Infant wide-field fundus photograph — 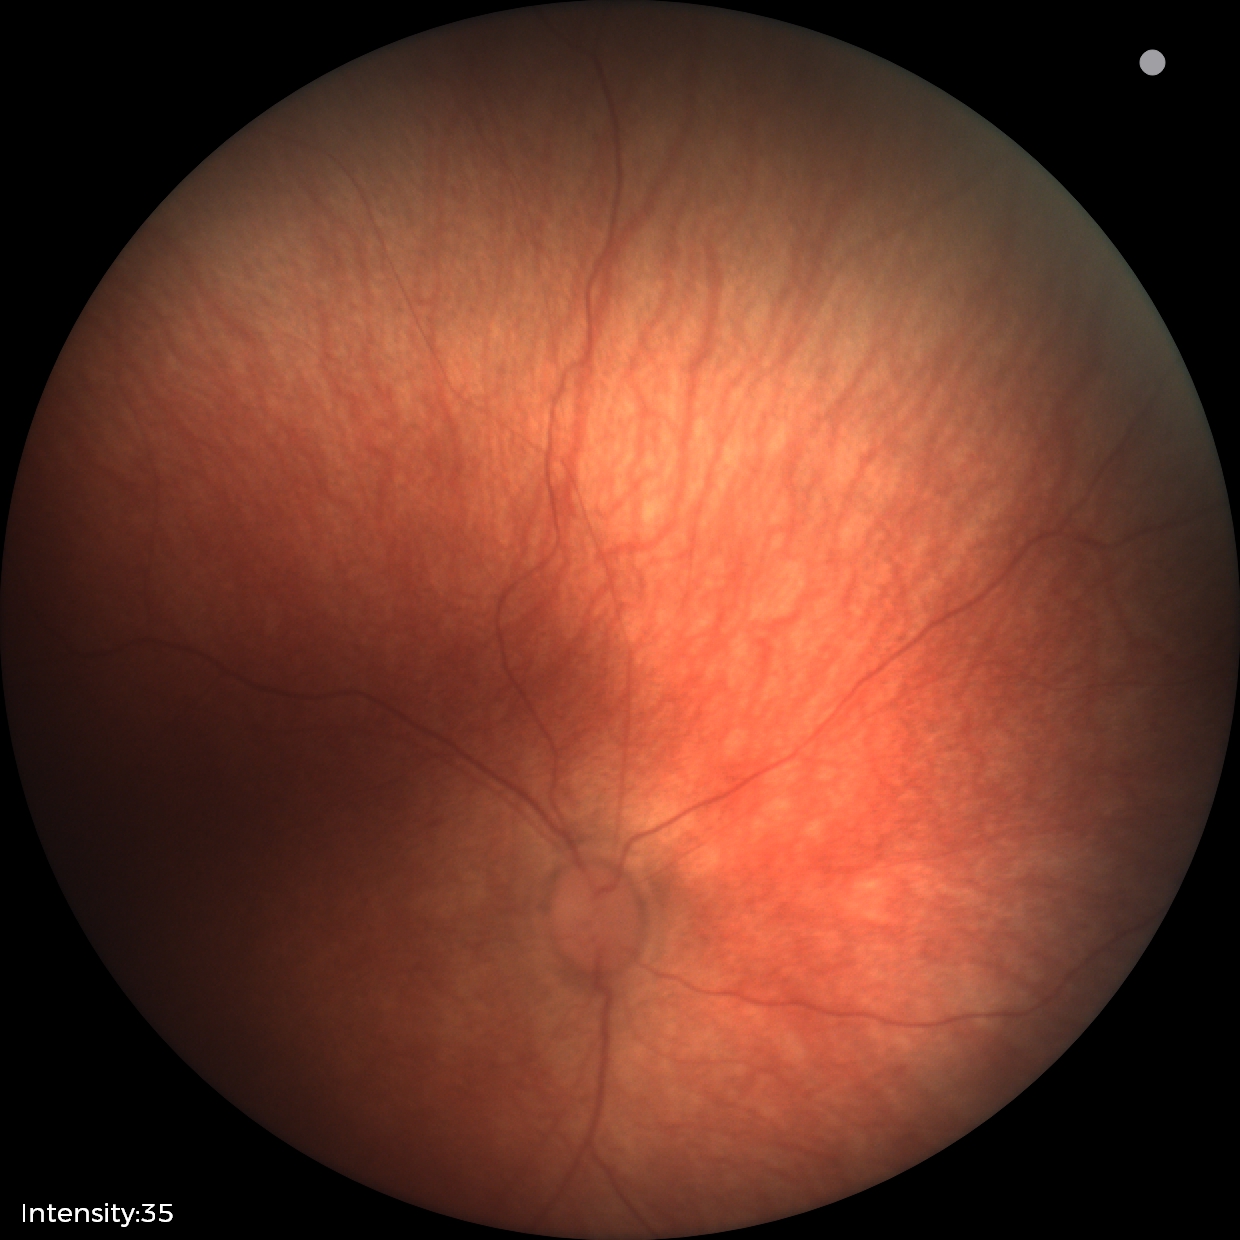
Screening examination with no abnormal retinal findings.